Graded on the modified Davis scale — 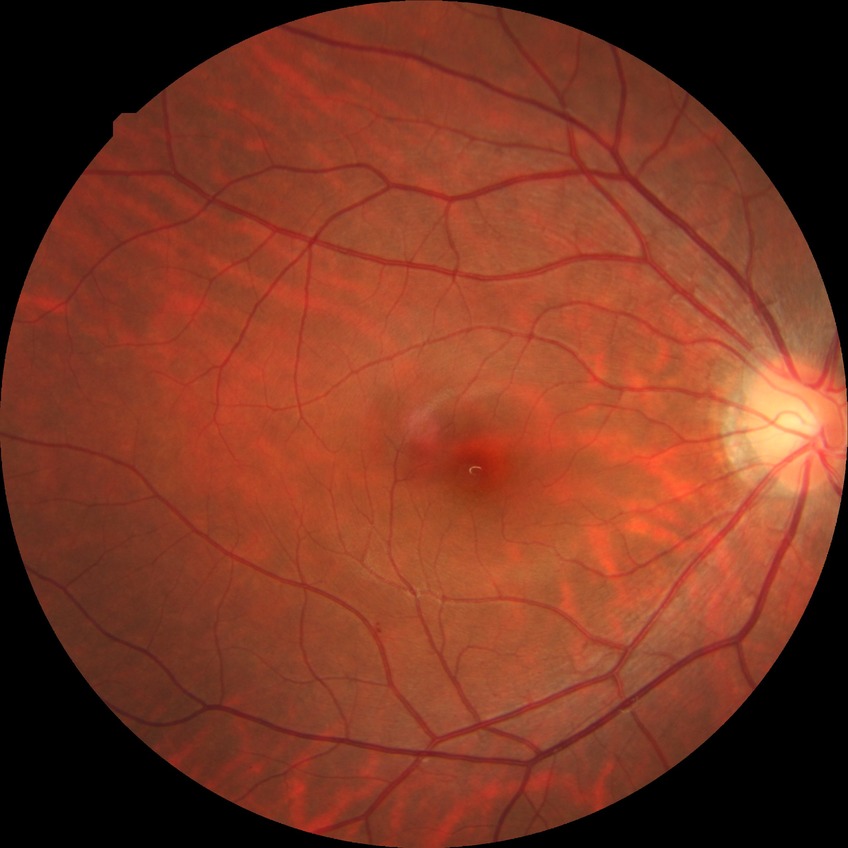

diabetic retinopathy (DR)=NDR (no diabetic retinopathy).